Infant wide-field retinal image:
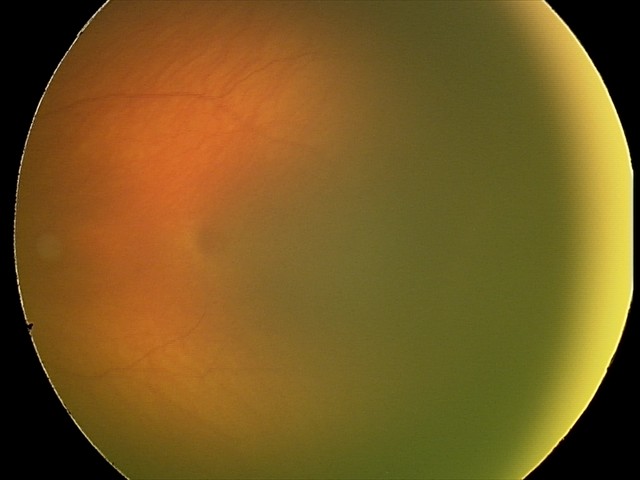
Q: What is the diagnosis from this examination?
A: retinopathy of prematurity stage 1